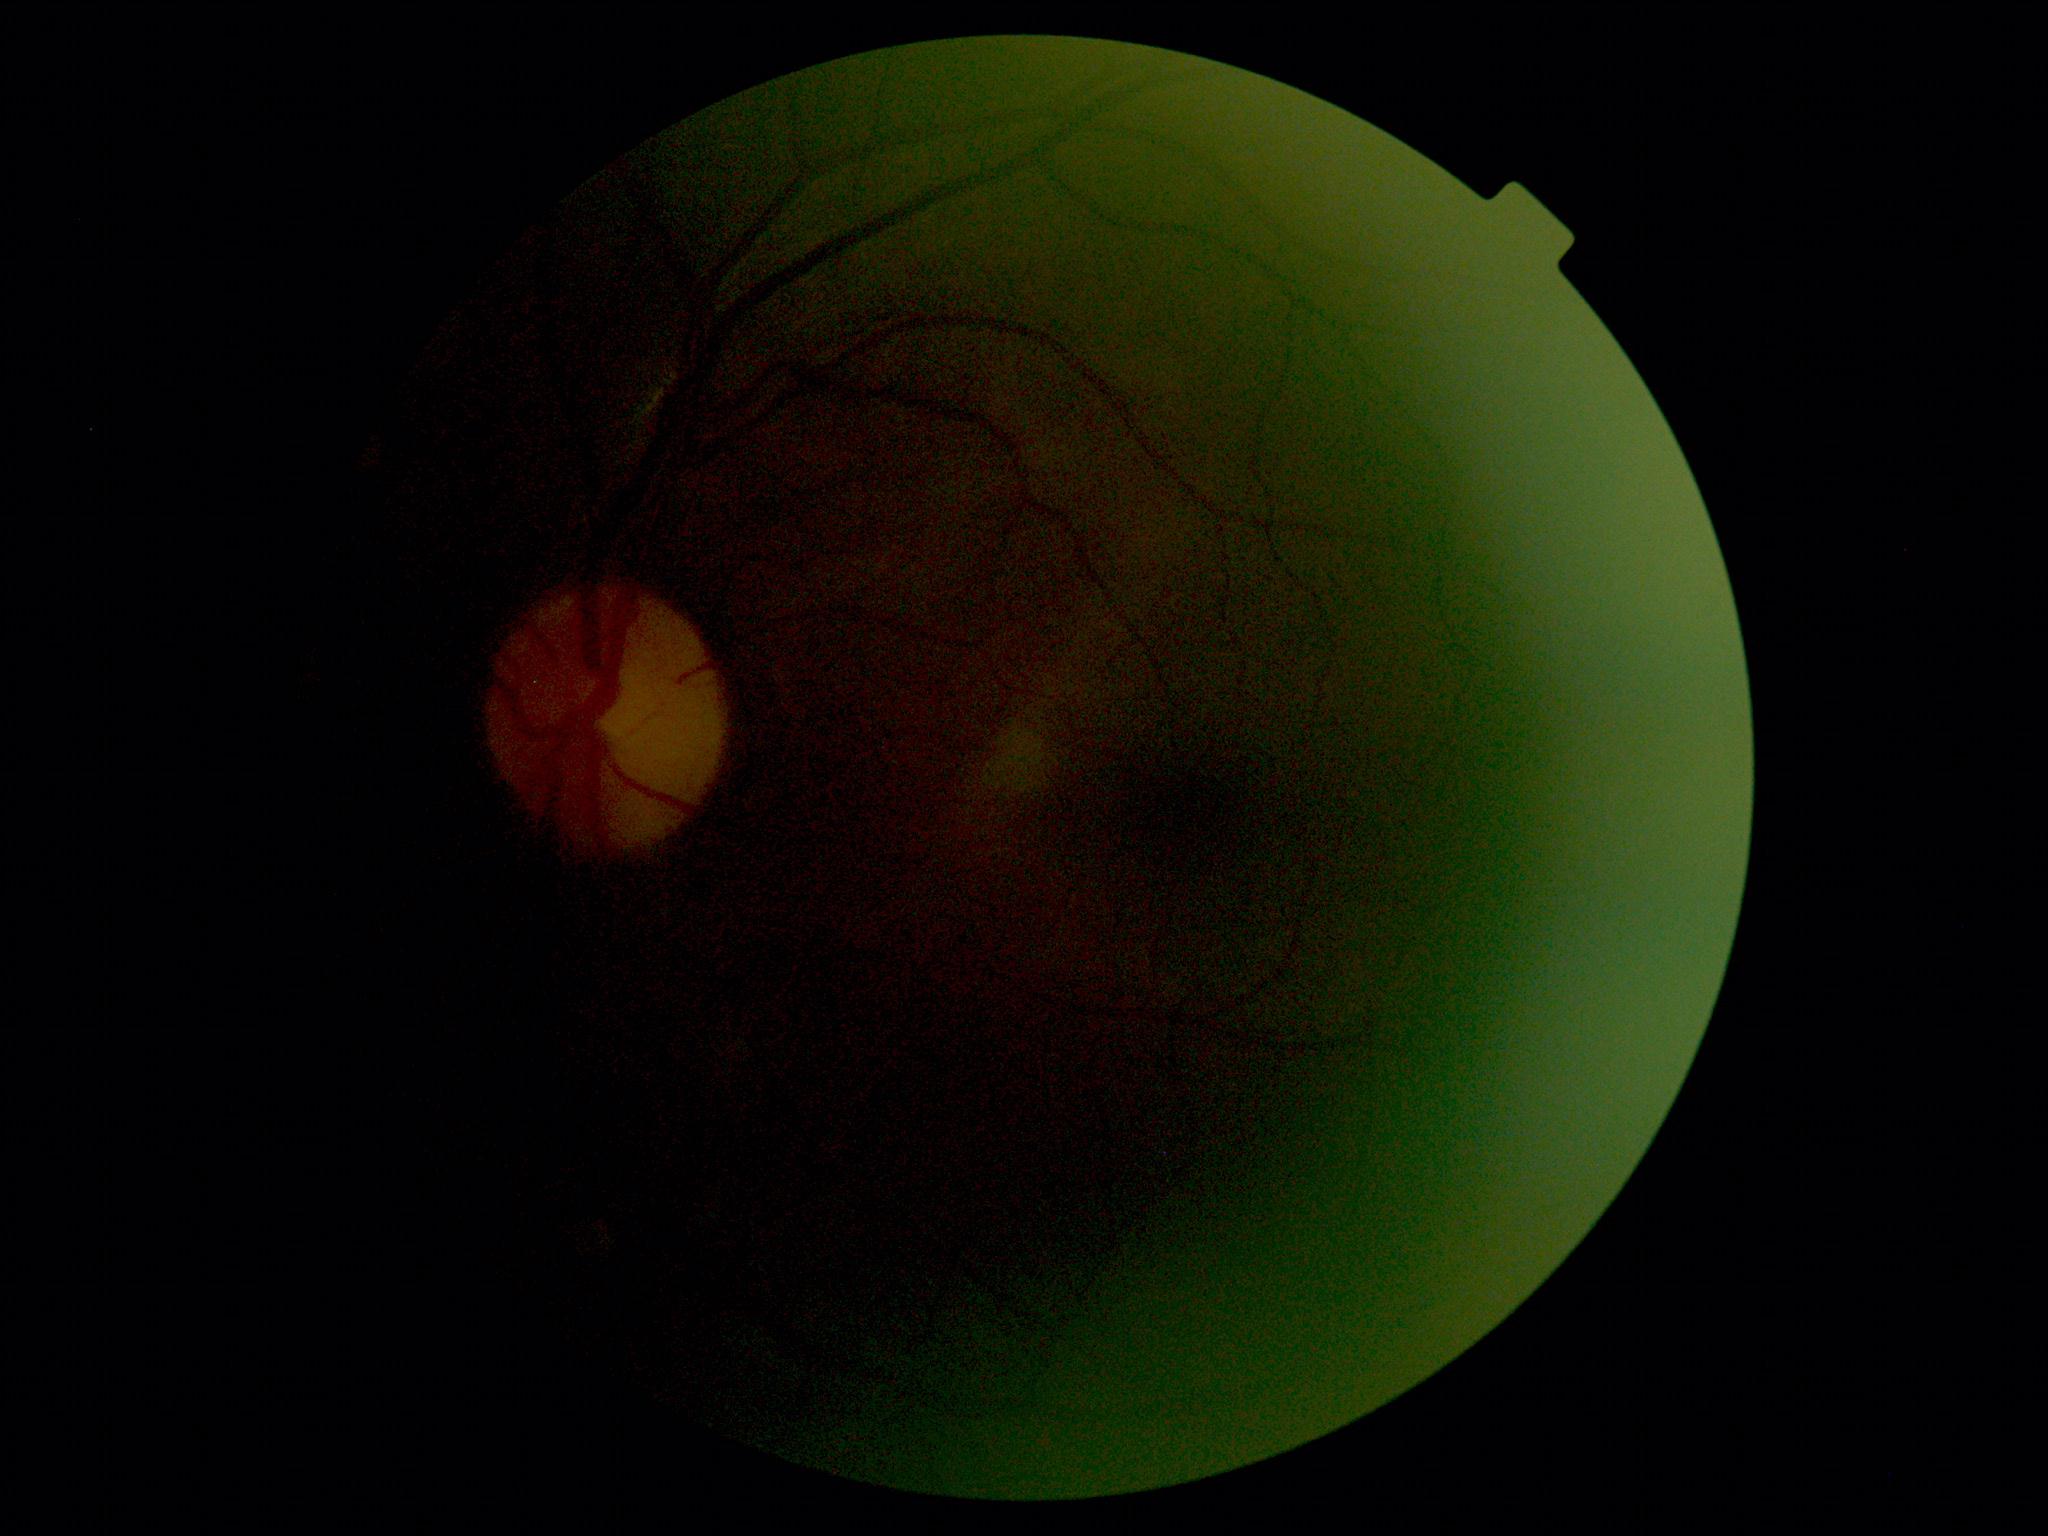

diabetic retinopathy grade: ungradable due to poor image quality; image quality: too poor for DR grading.